Wide-field fundus photograph of an infant
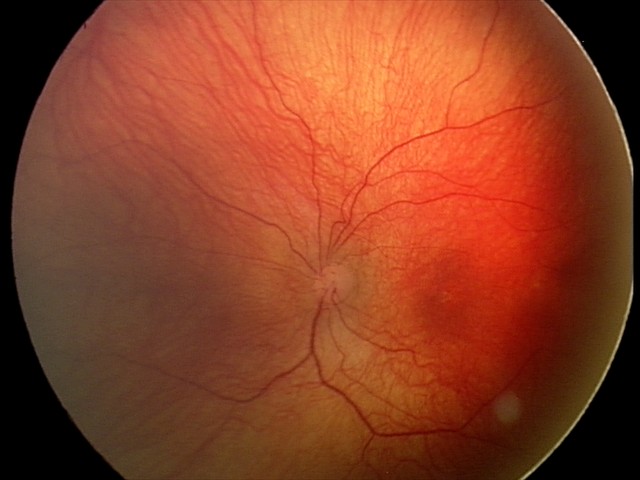 Examination diagnosed as status post retinopathy of prematurity (ROP).
Plus disease absent.